Color fundus image; 45° field of view; 2212 by 1672 pixels: 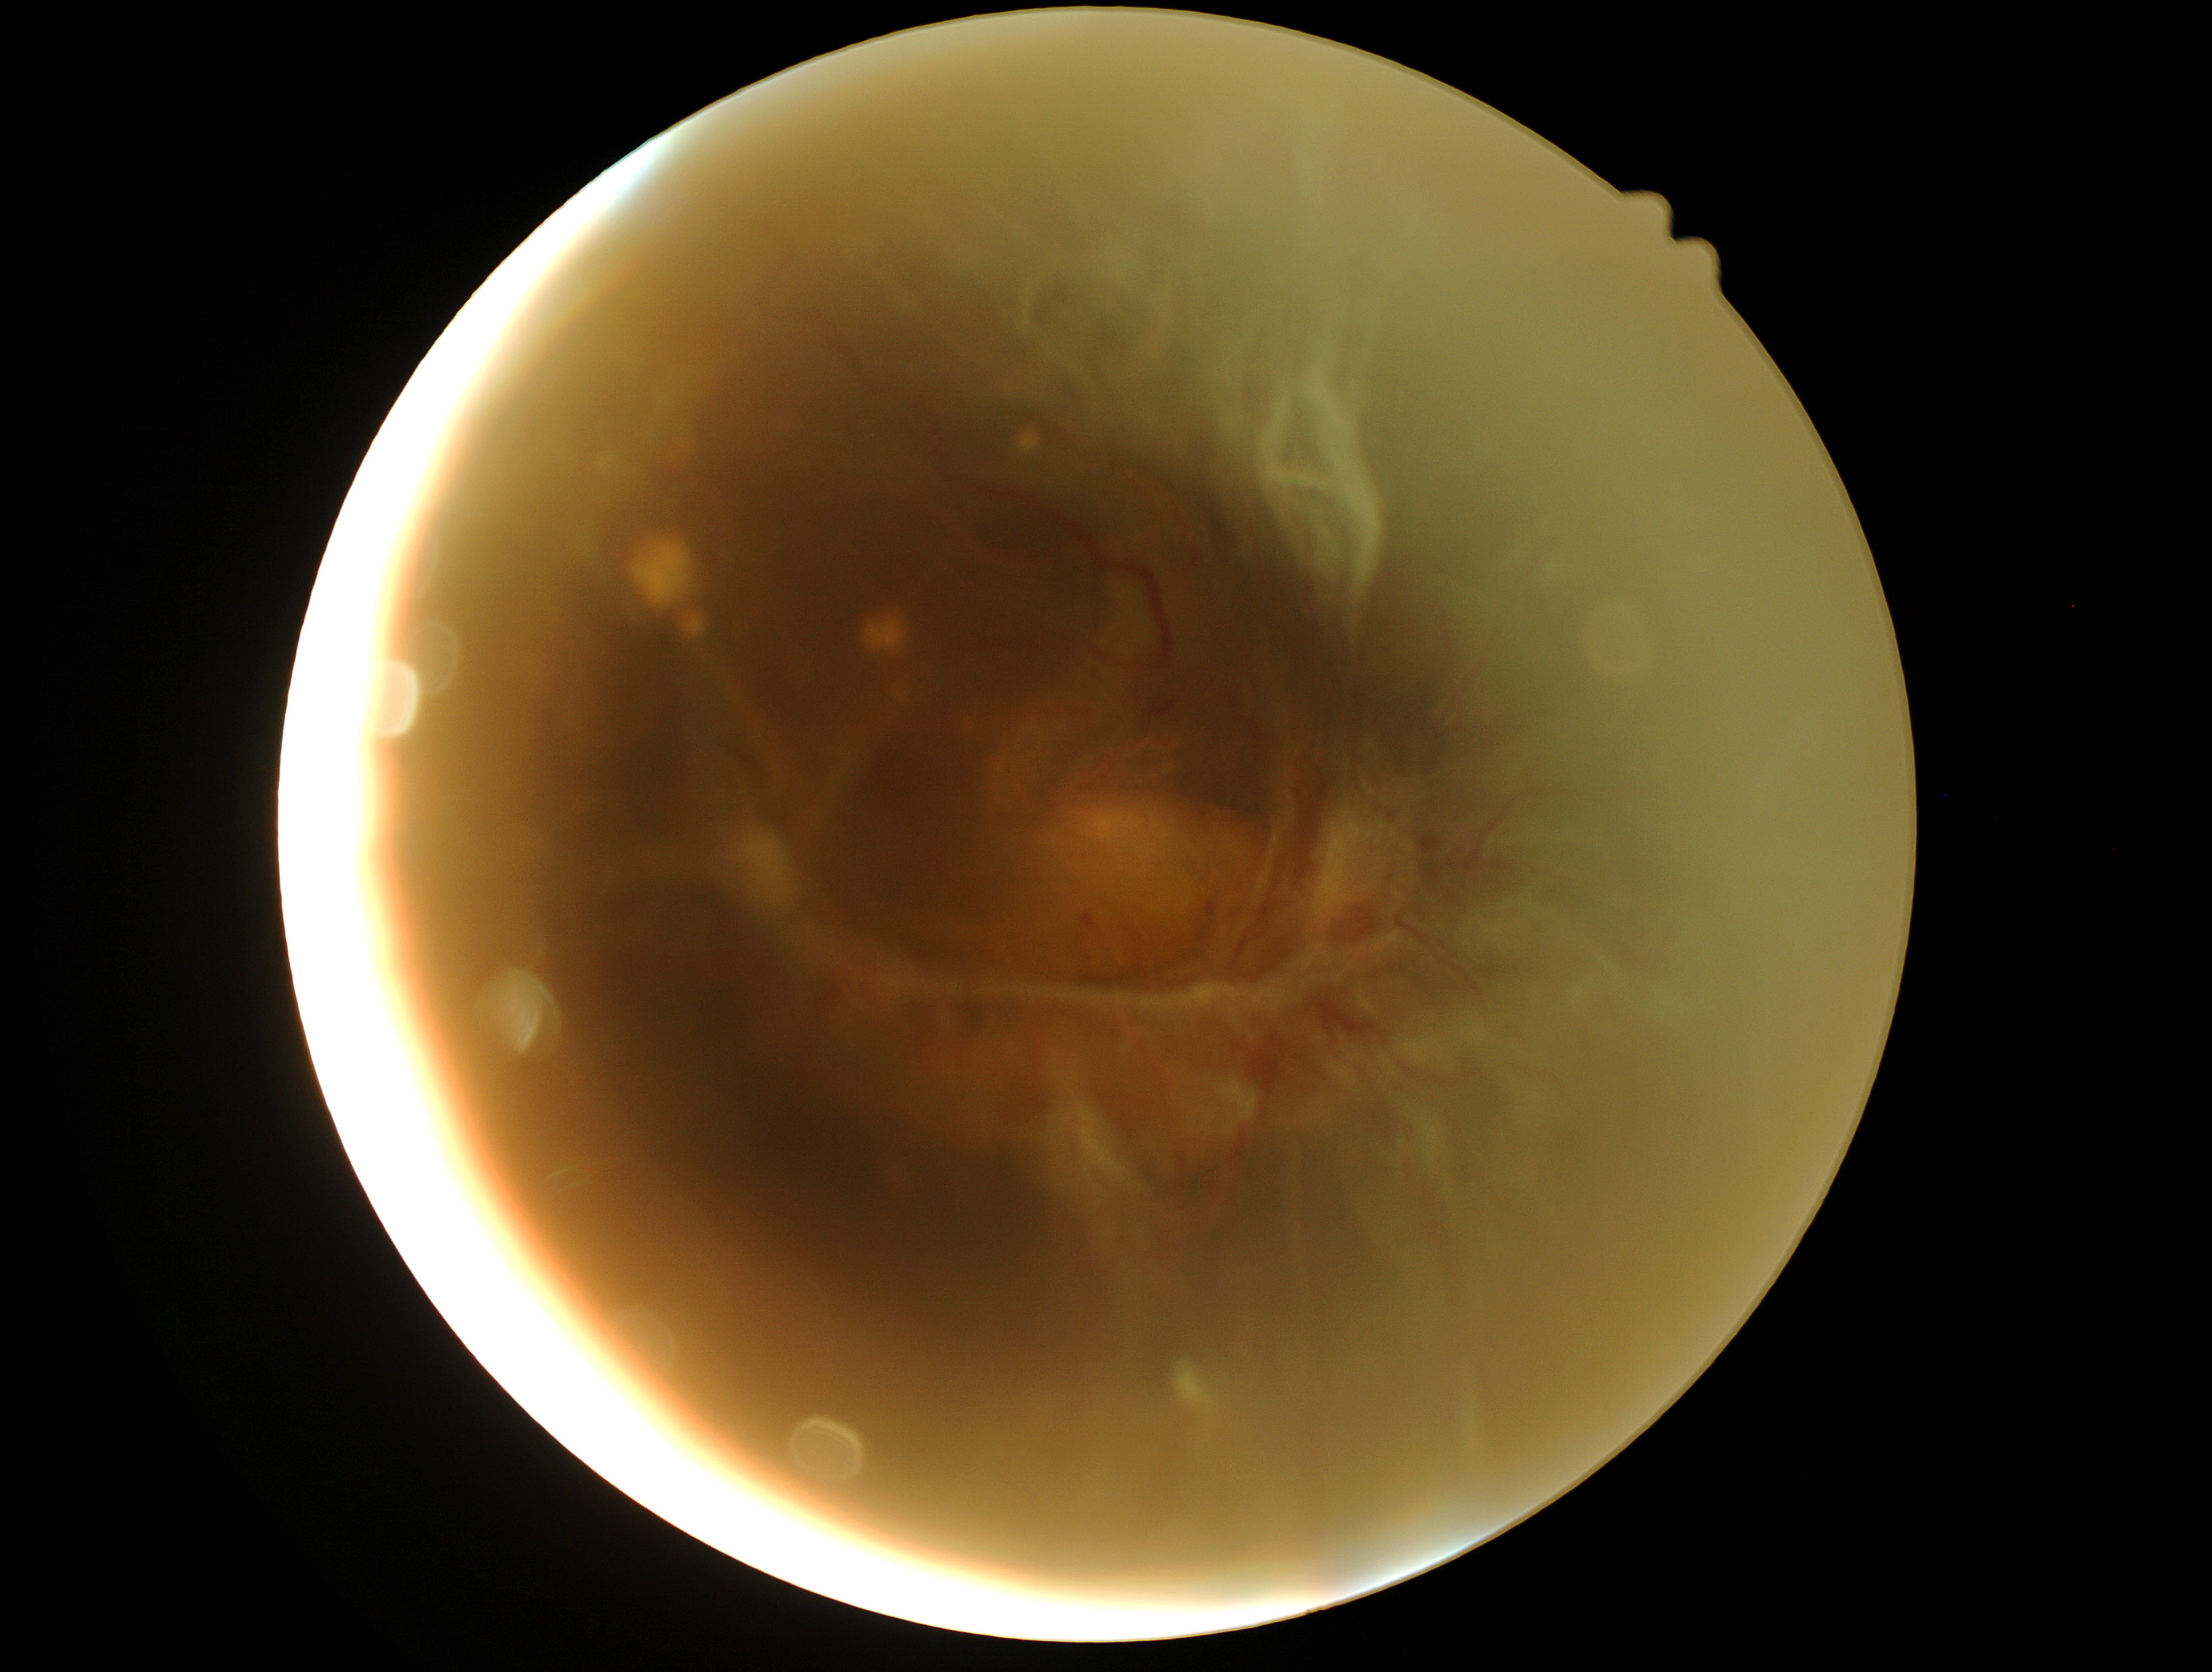
Retinopathy grade: proliferative diabetic retinopathy (4).